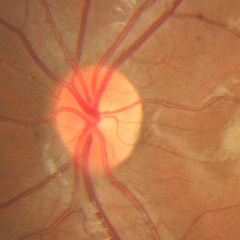

Demonstrates no glaucoma.